Infant wide-field fundus photograph: 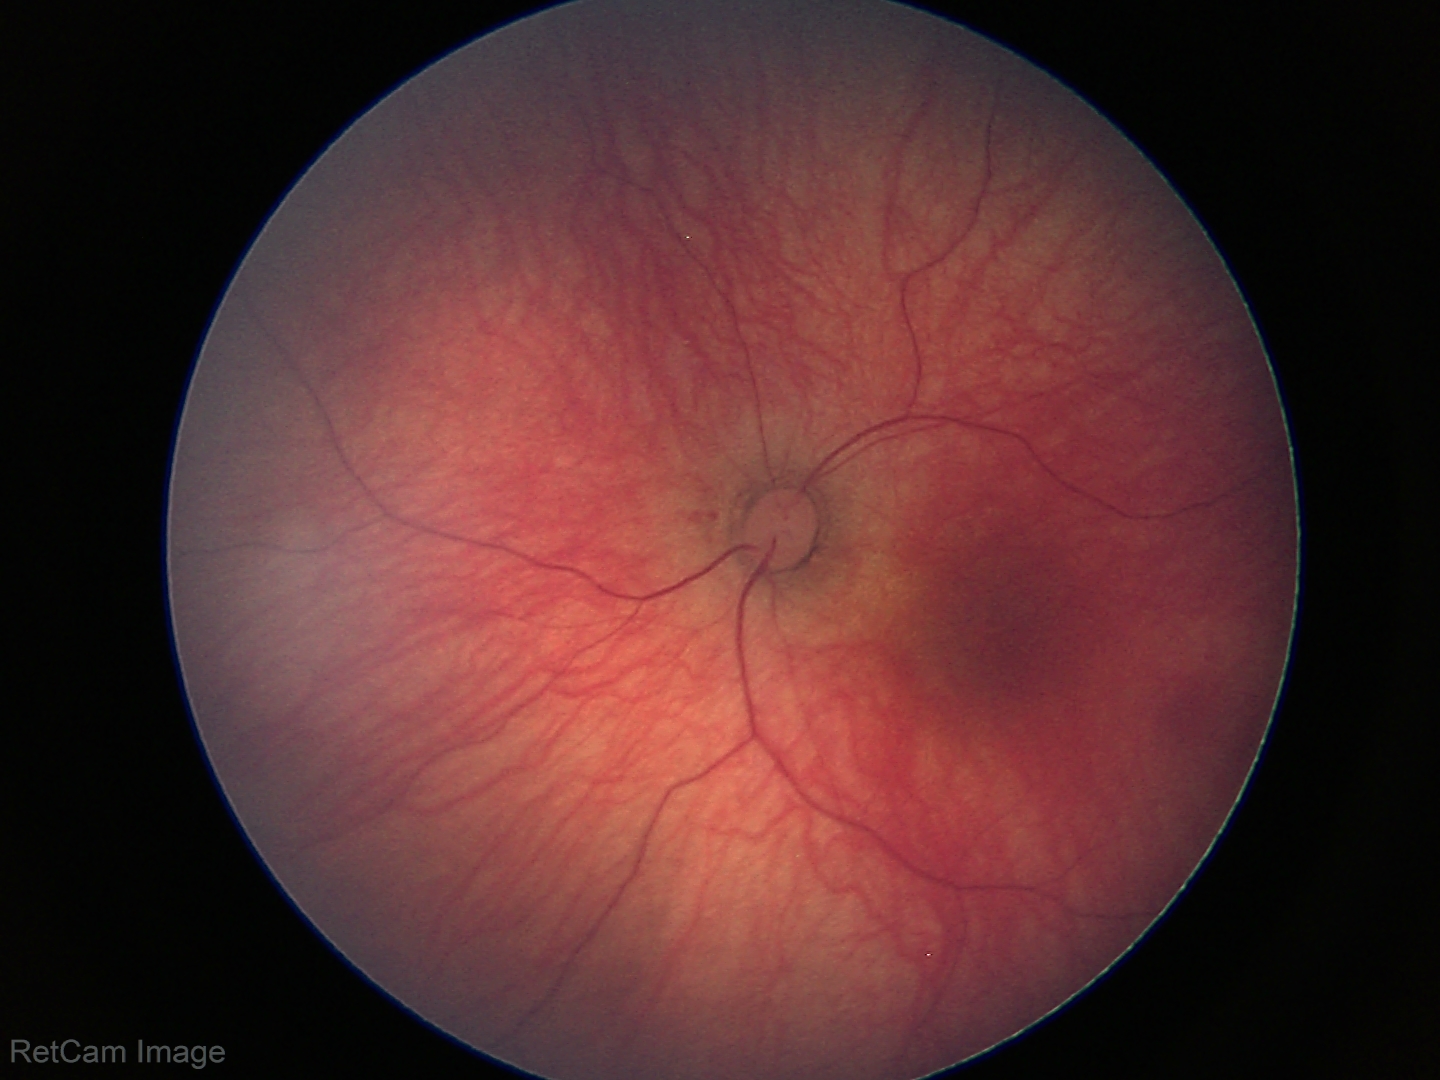

Screening diagnosis: normal.